FOV: 45 degrees · color fundus photograph · image size 1380x1382 — 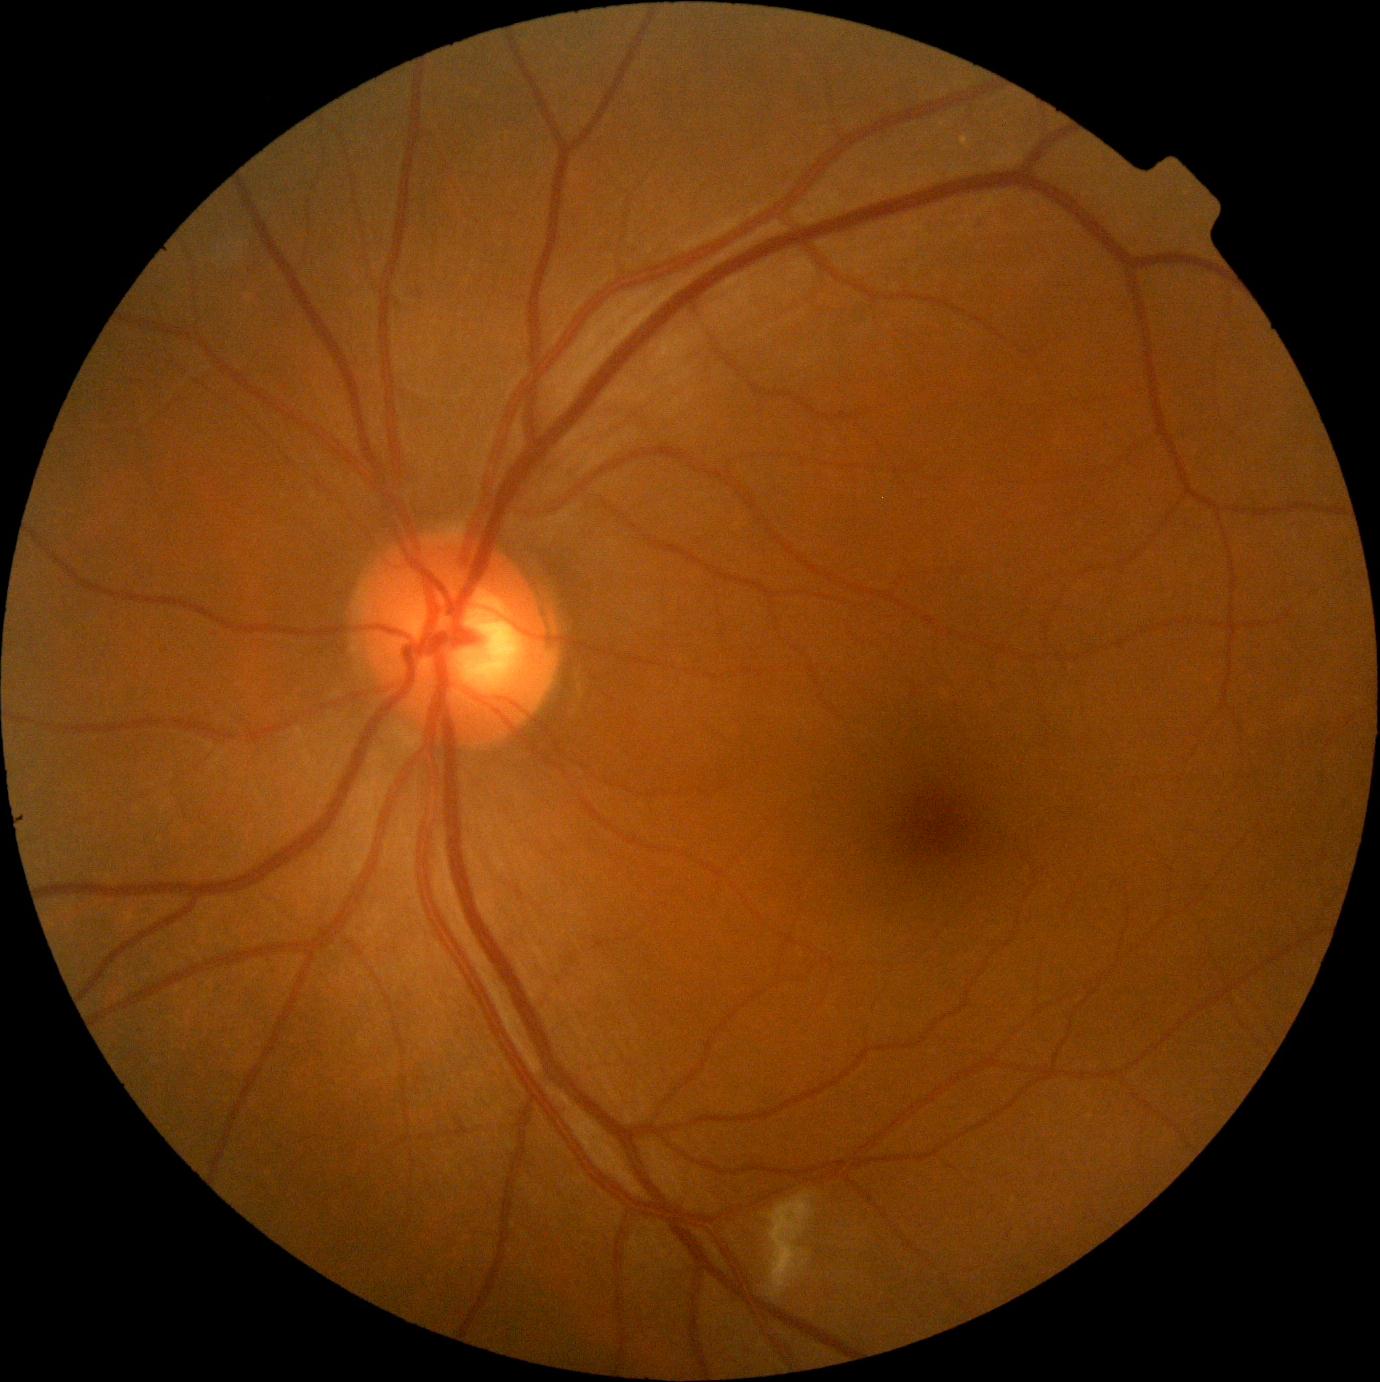

– retinopathy — grade 2